Phoenix ICON, 100° FOV. Wide-field fundus photograph from neonatal ROP screening.
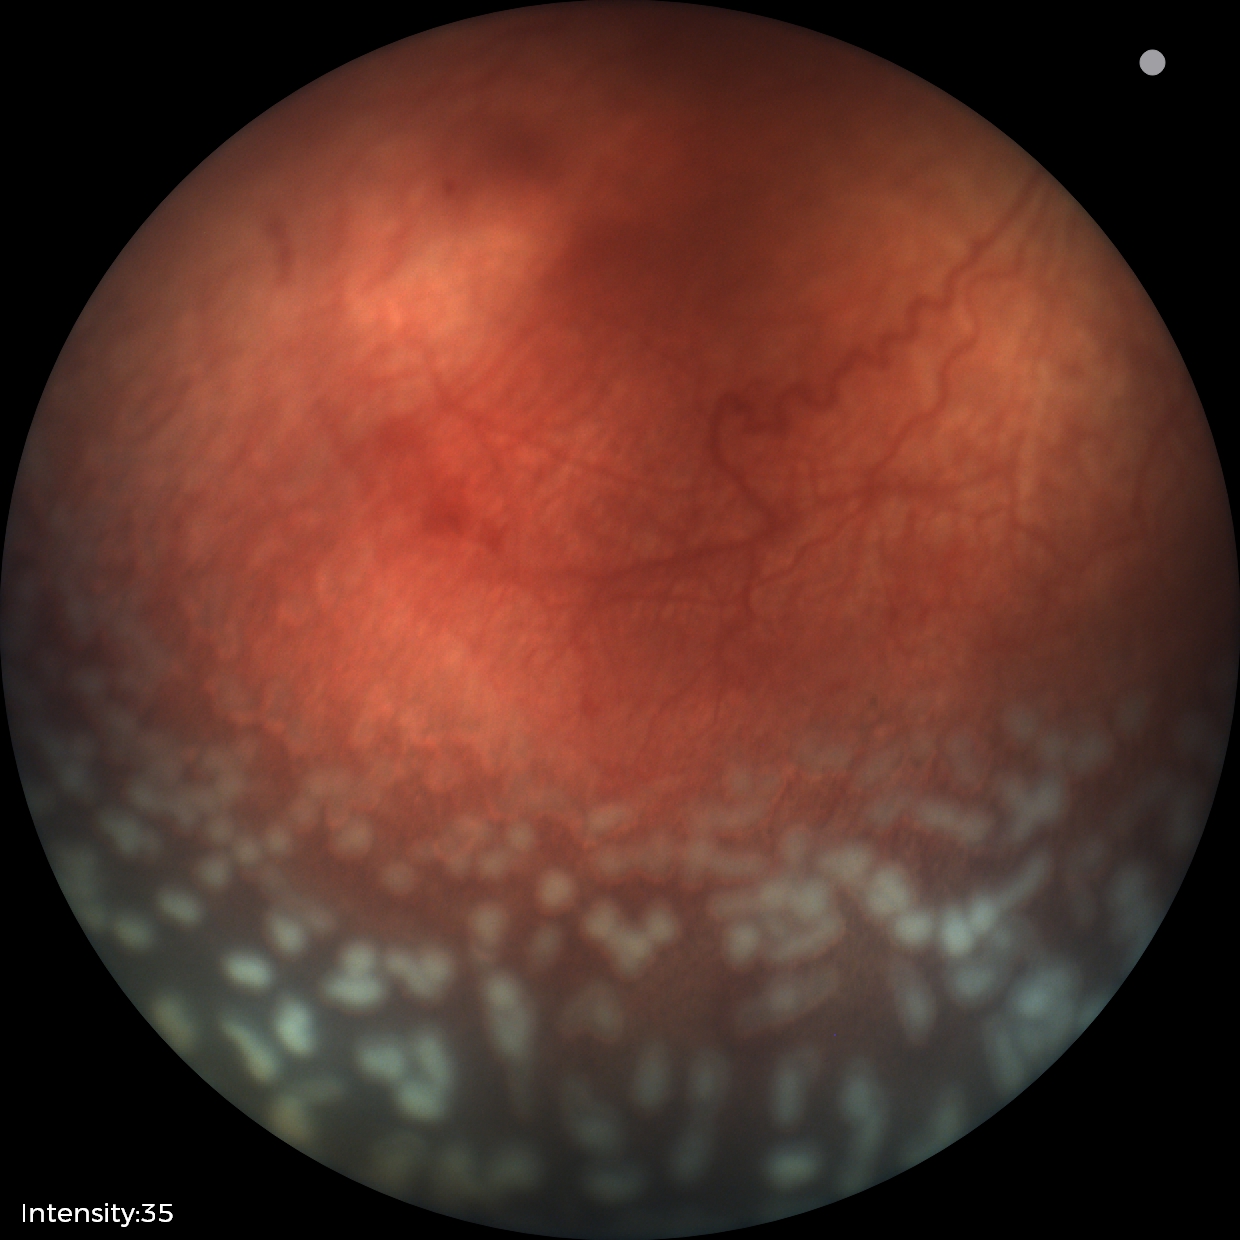
Screening series with ROP stage 2.